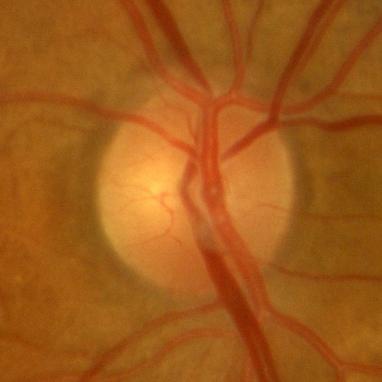
This optic disc photograph shows no glaucomatous optic neuropathy.